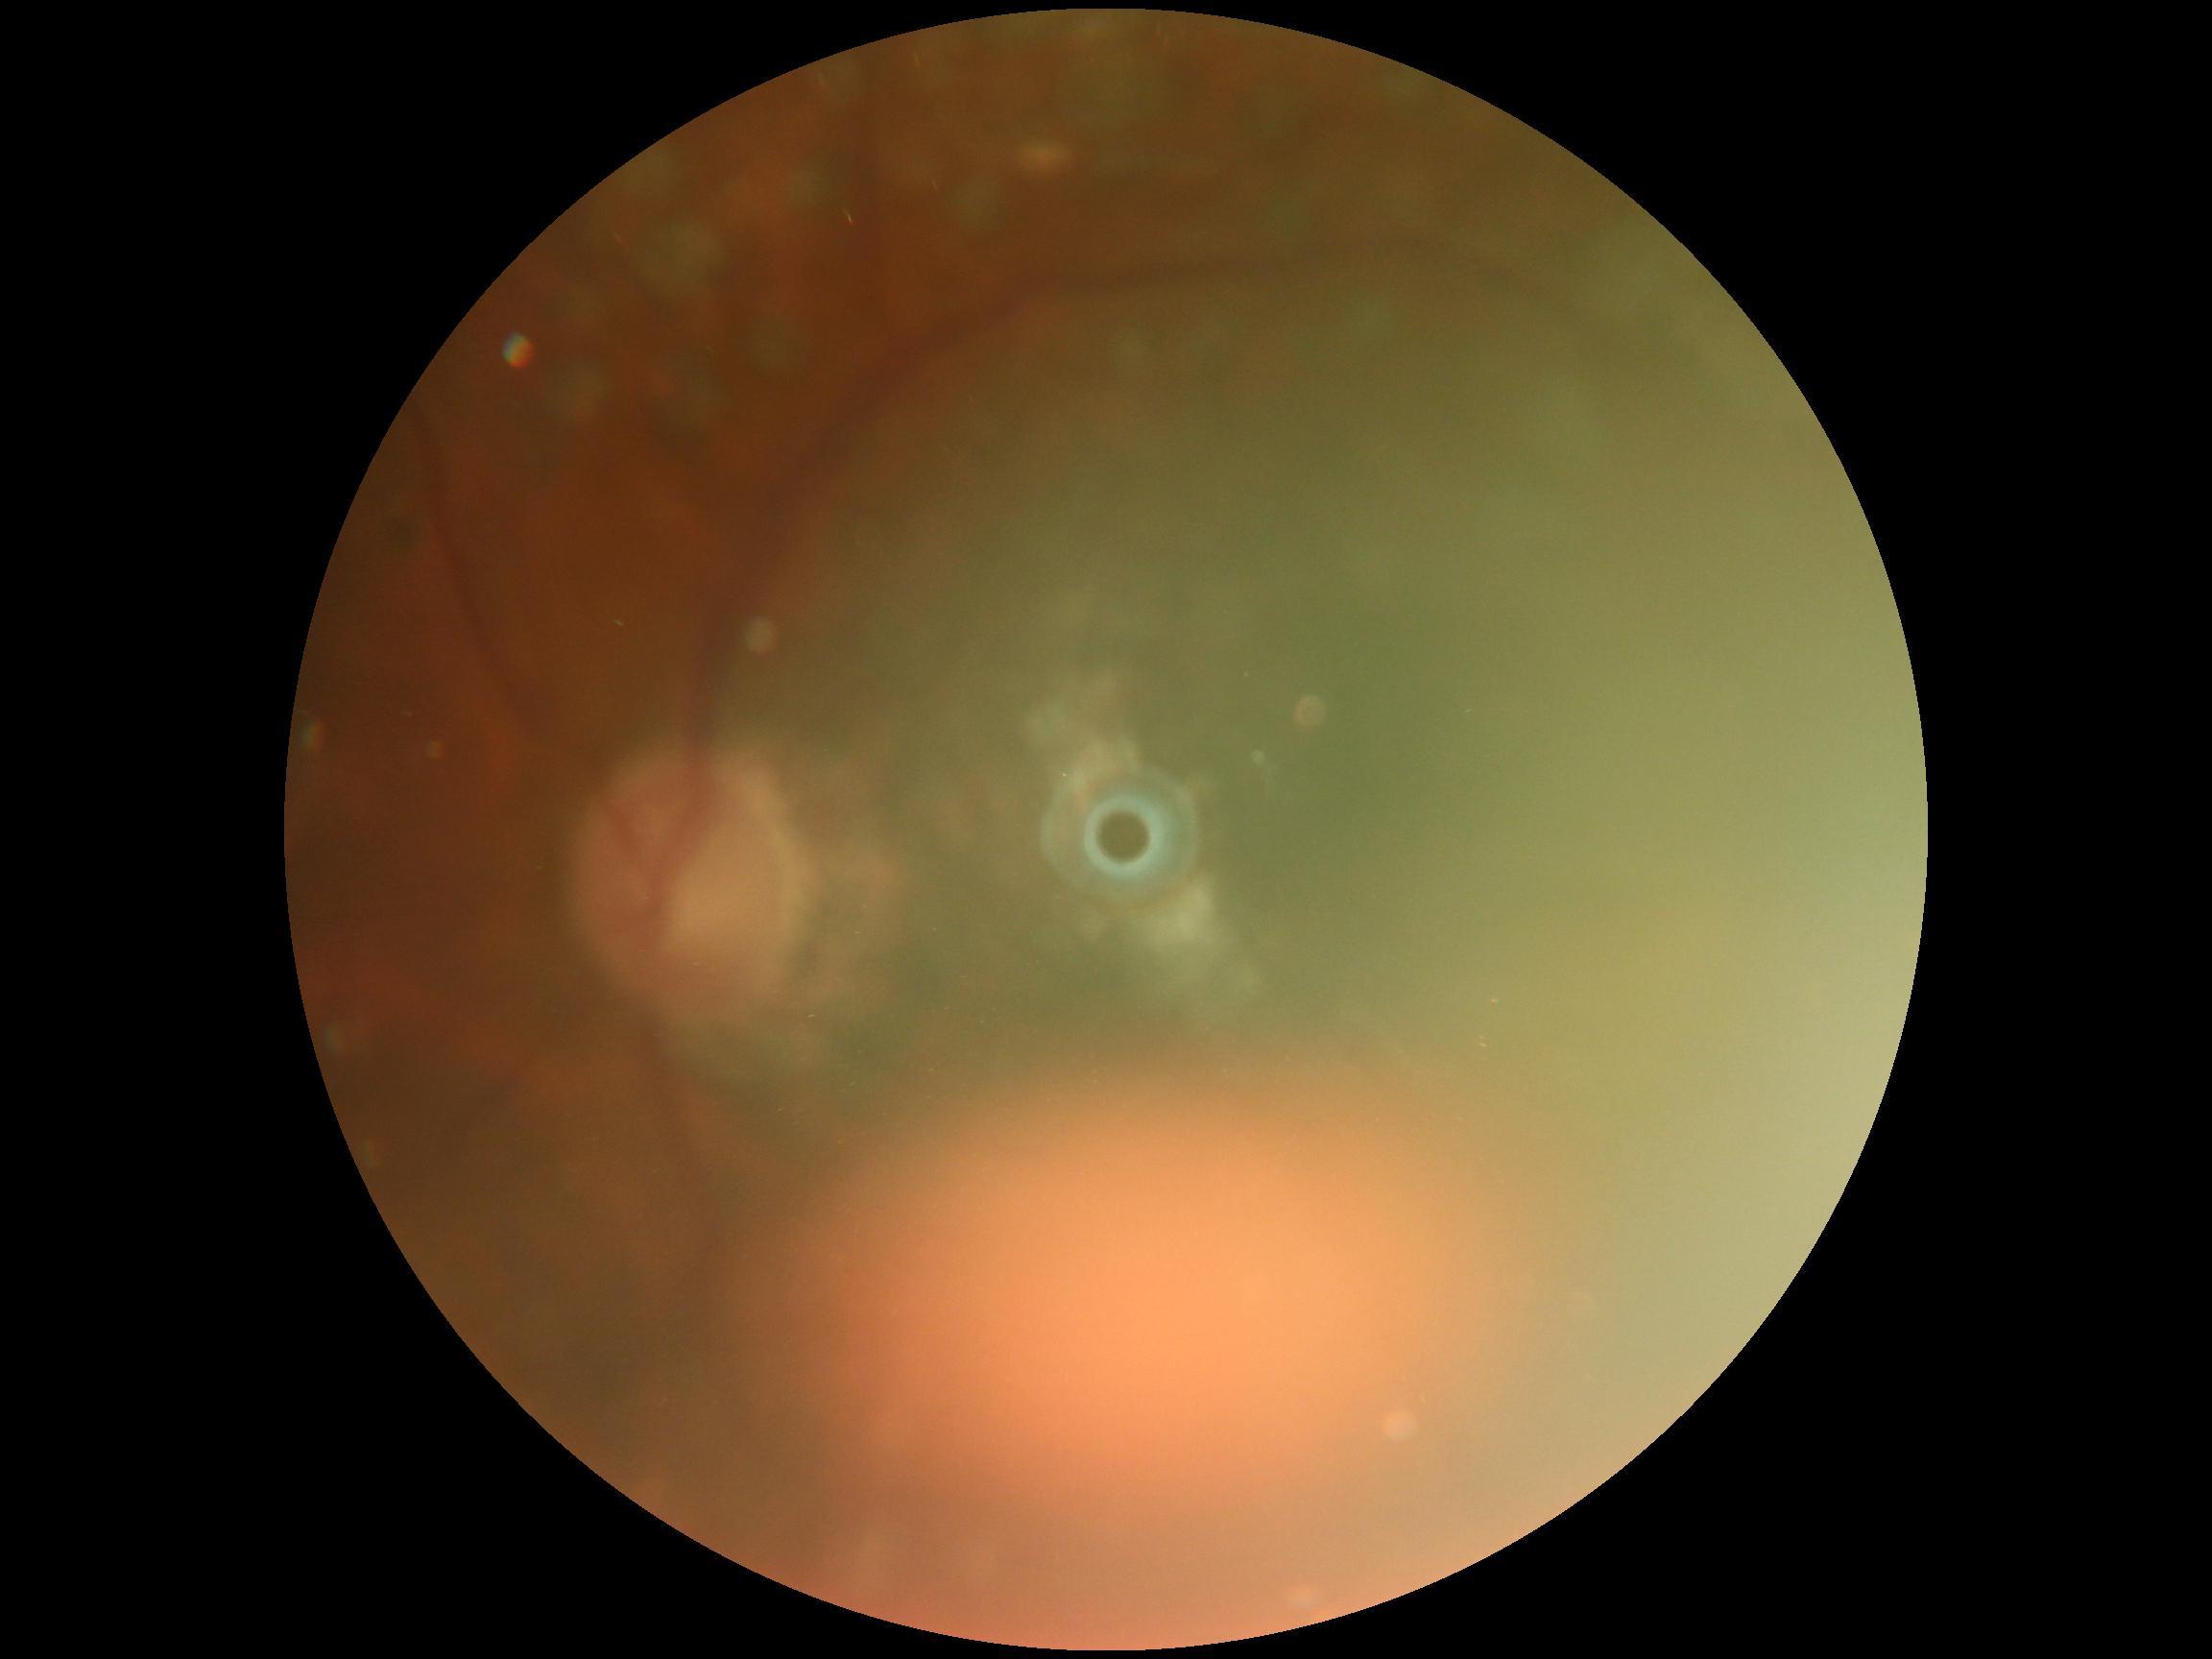

DR severity: ungradable.